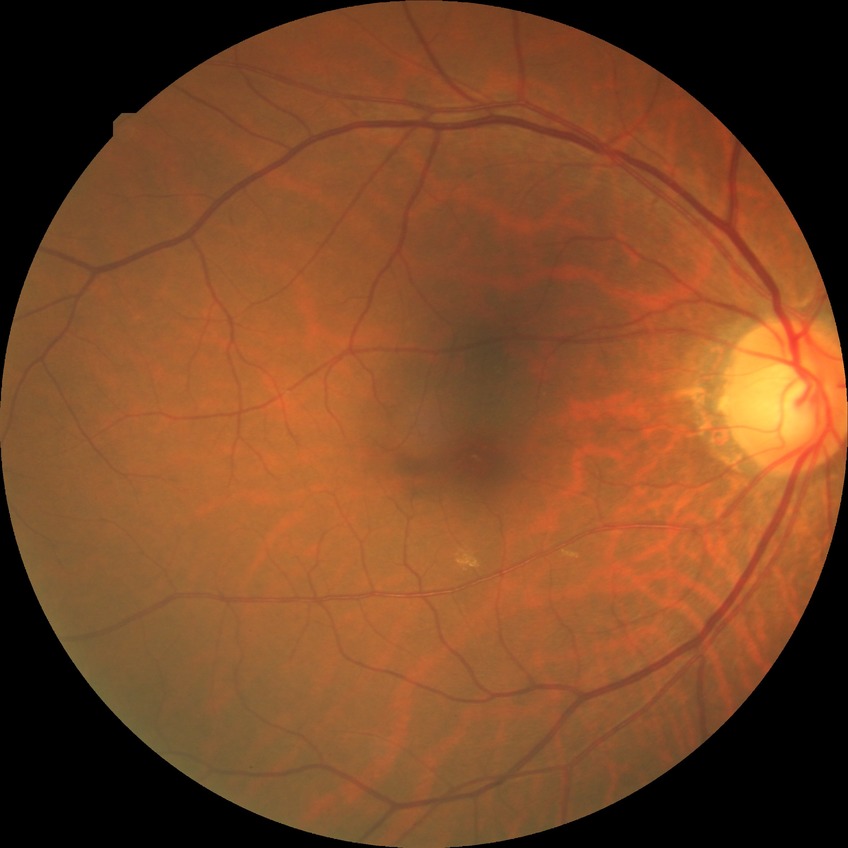
Retinopathy grade: no diabetic retinopathy.